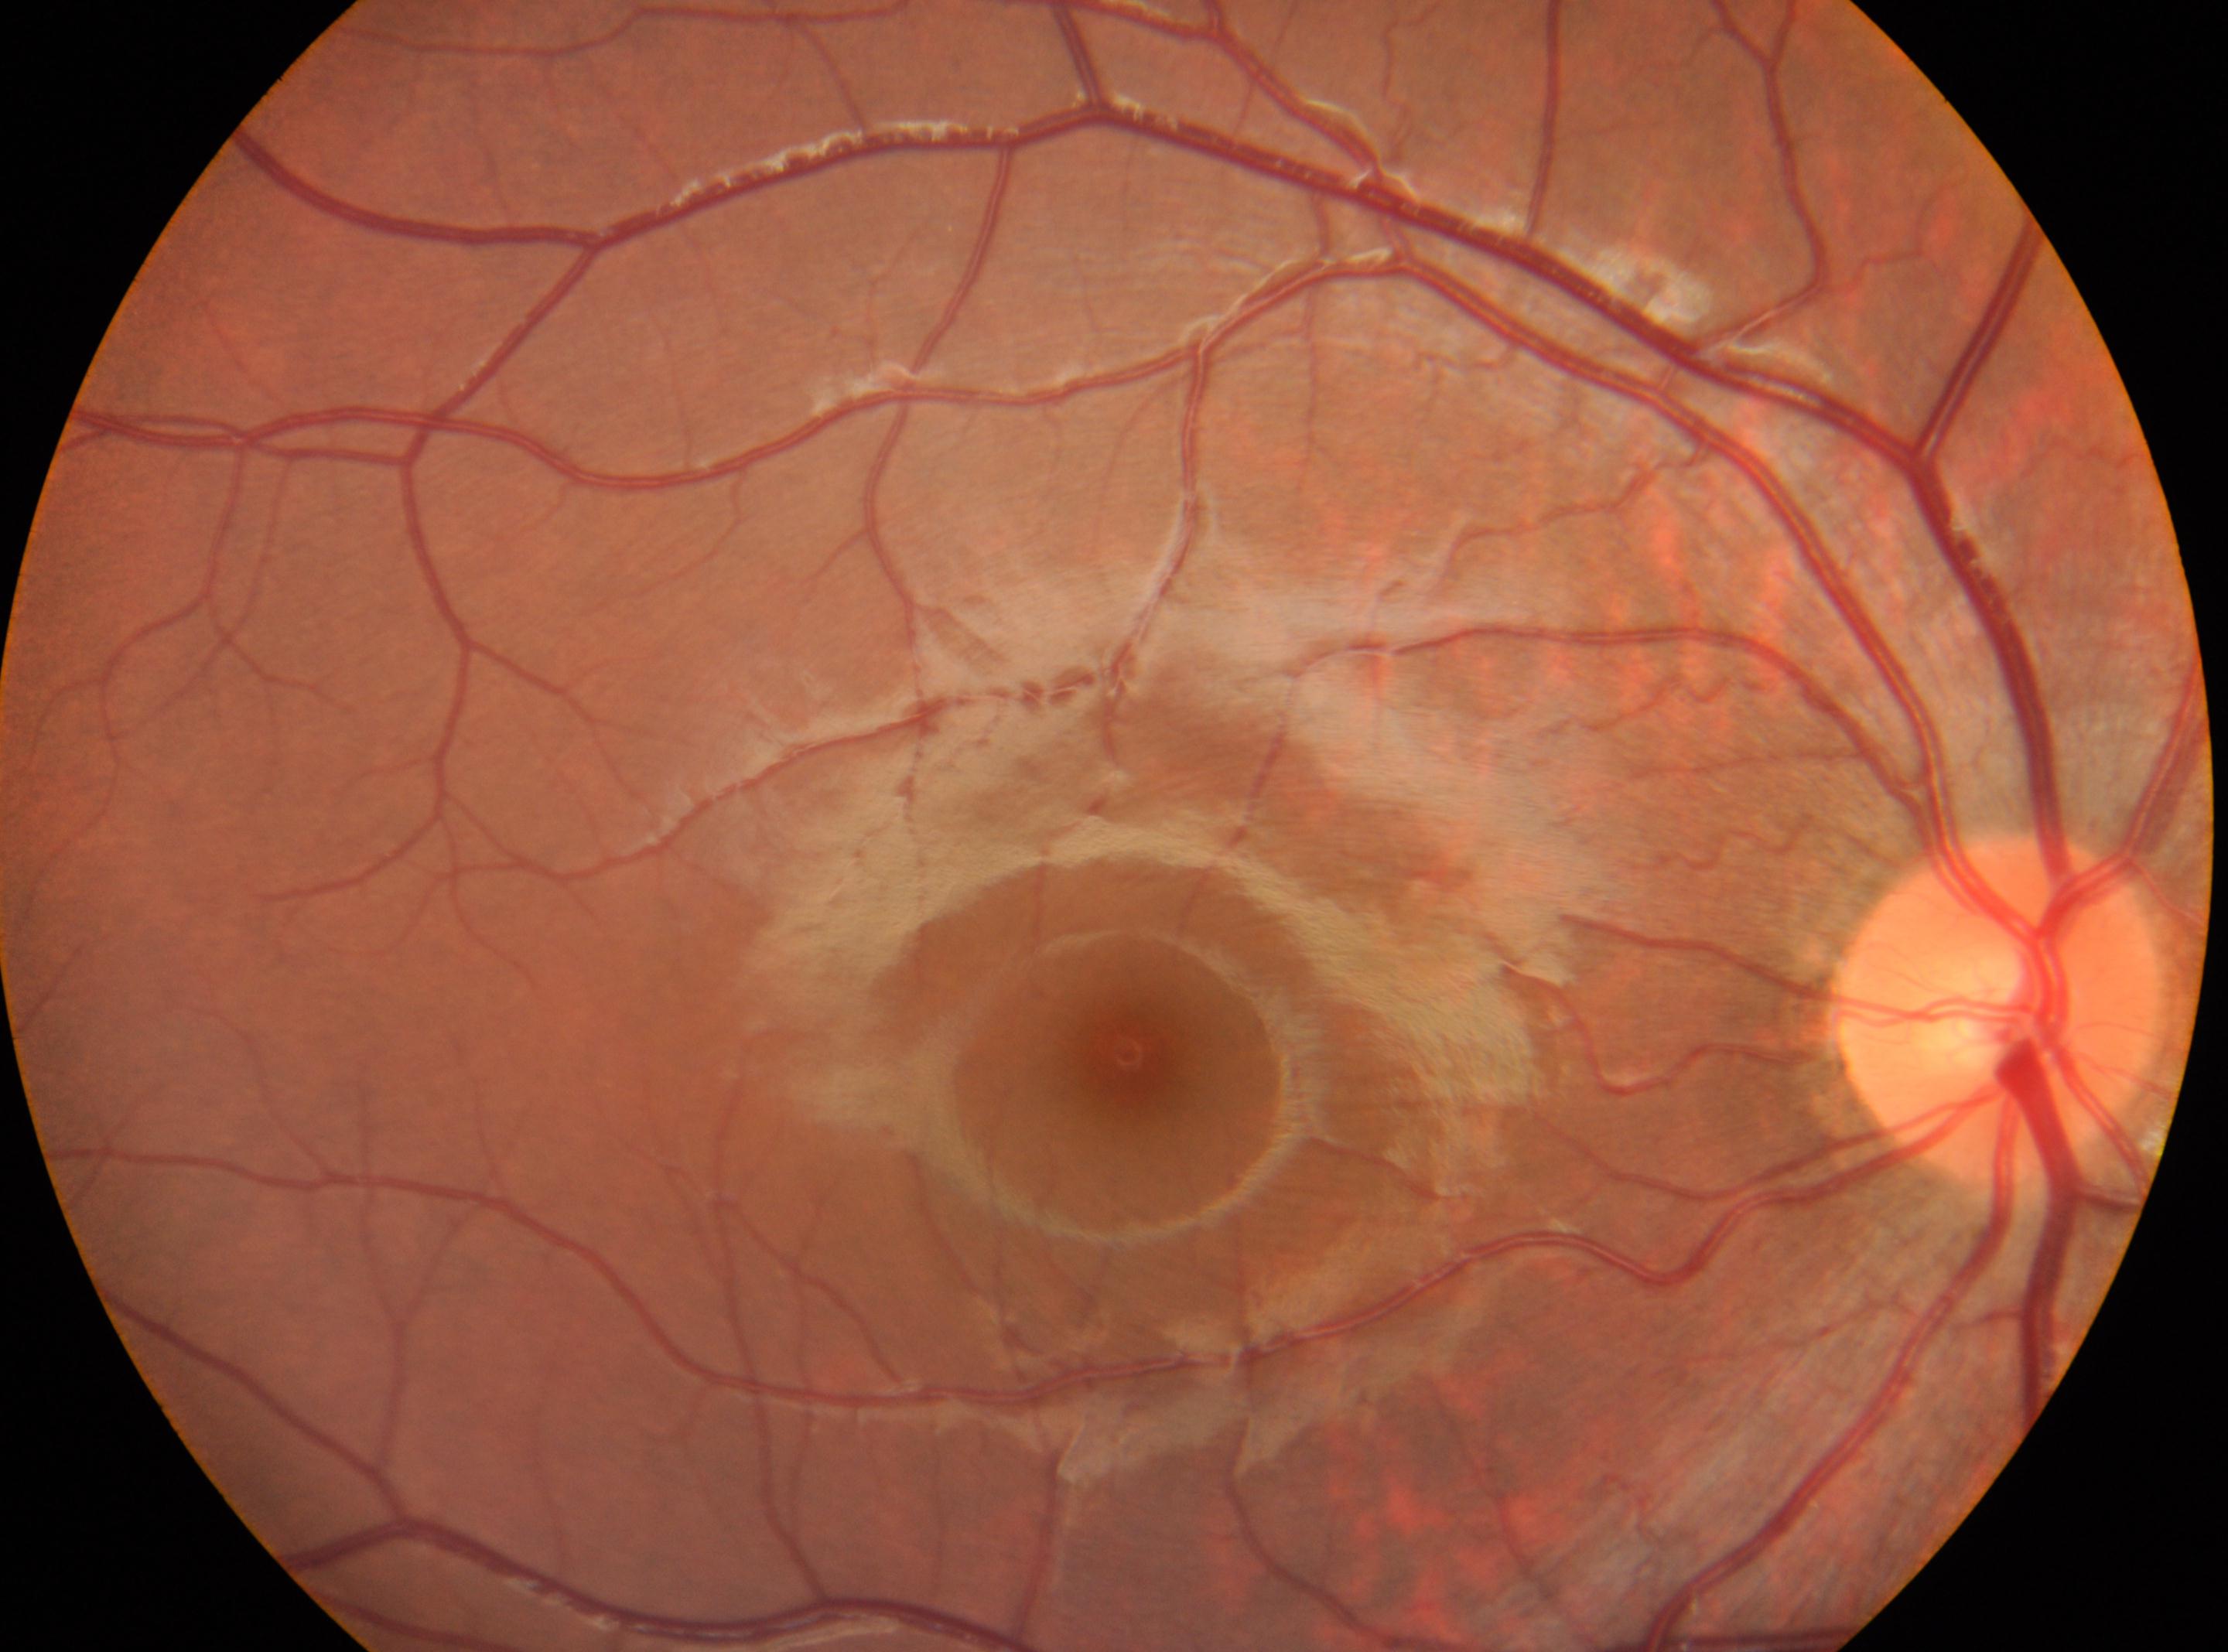 optic nerve head: 2000px, 1012px
foveal center: 1129px, 1058px
diabetic retinopathy (DR): no apparent diabetic retinopathy (grade 0)
the right eye